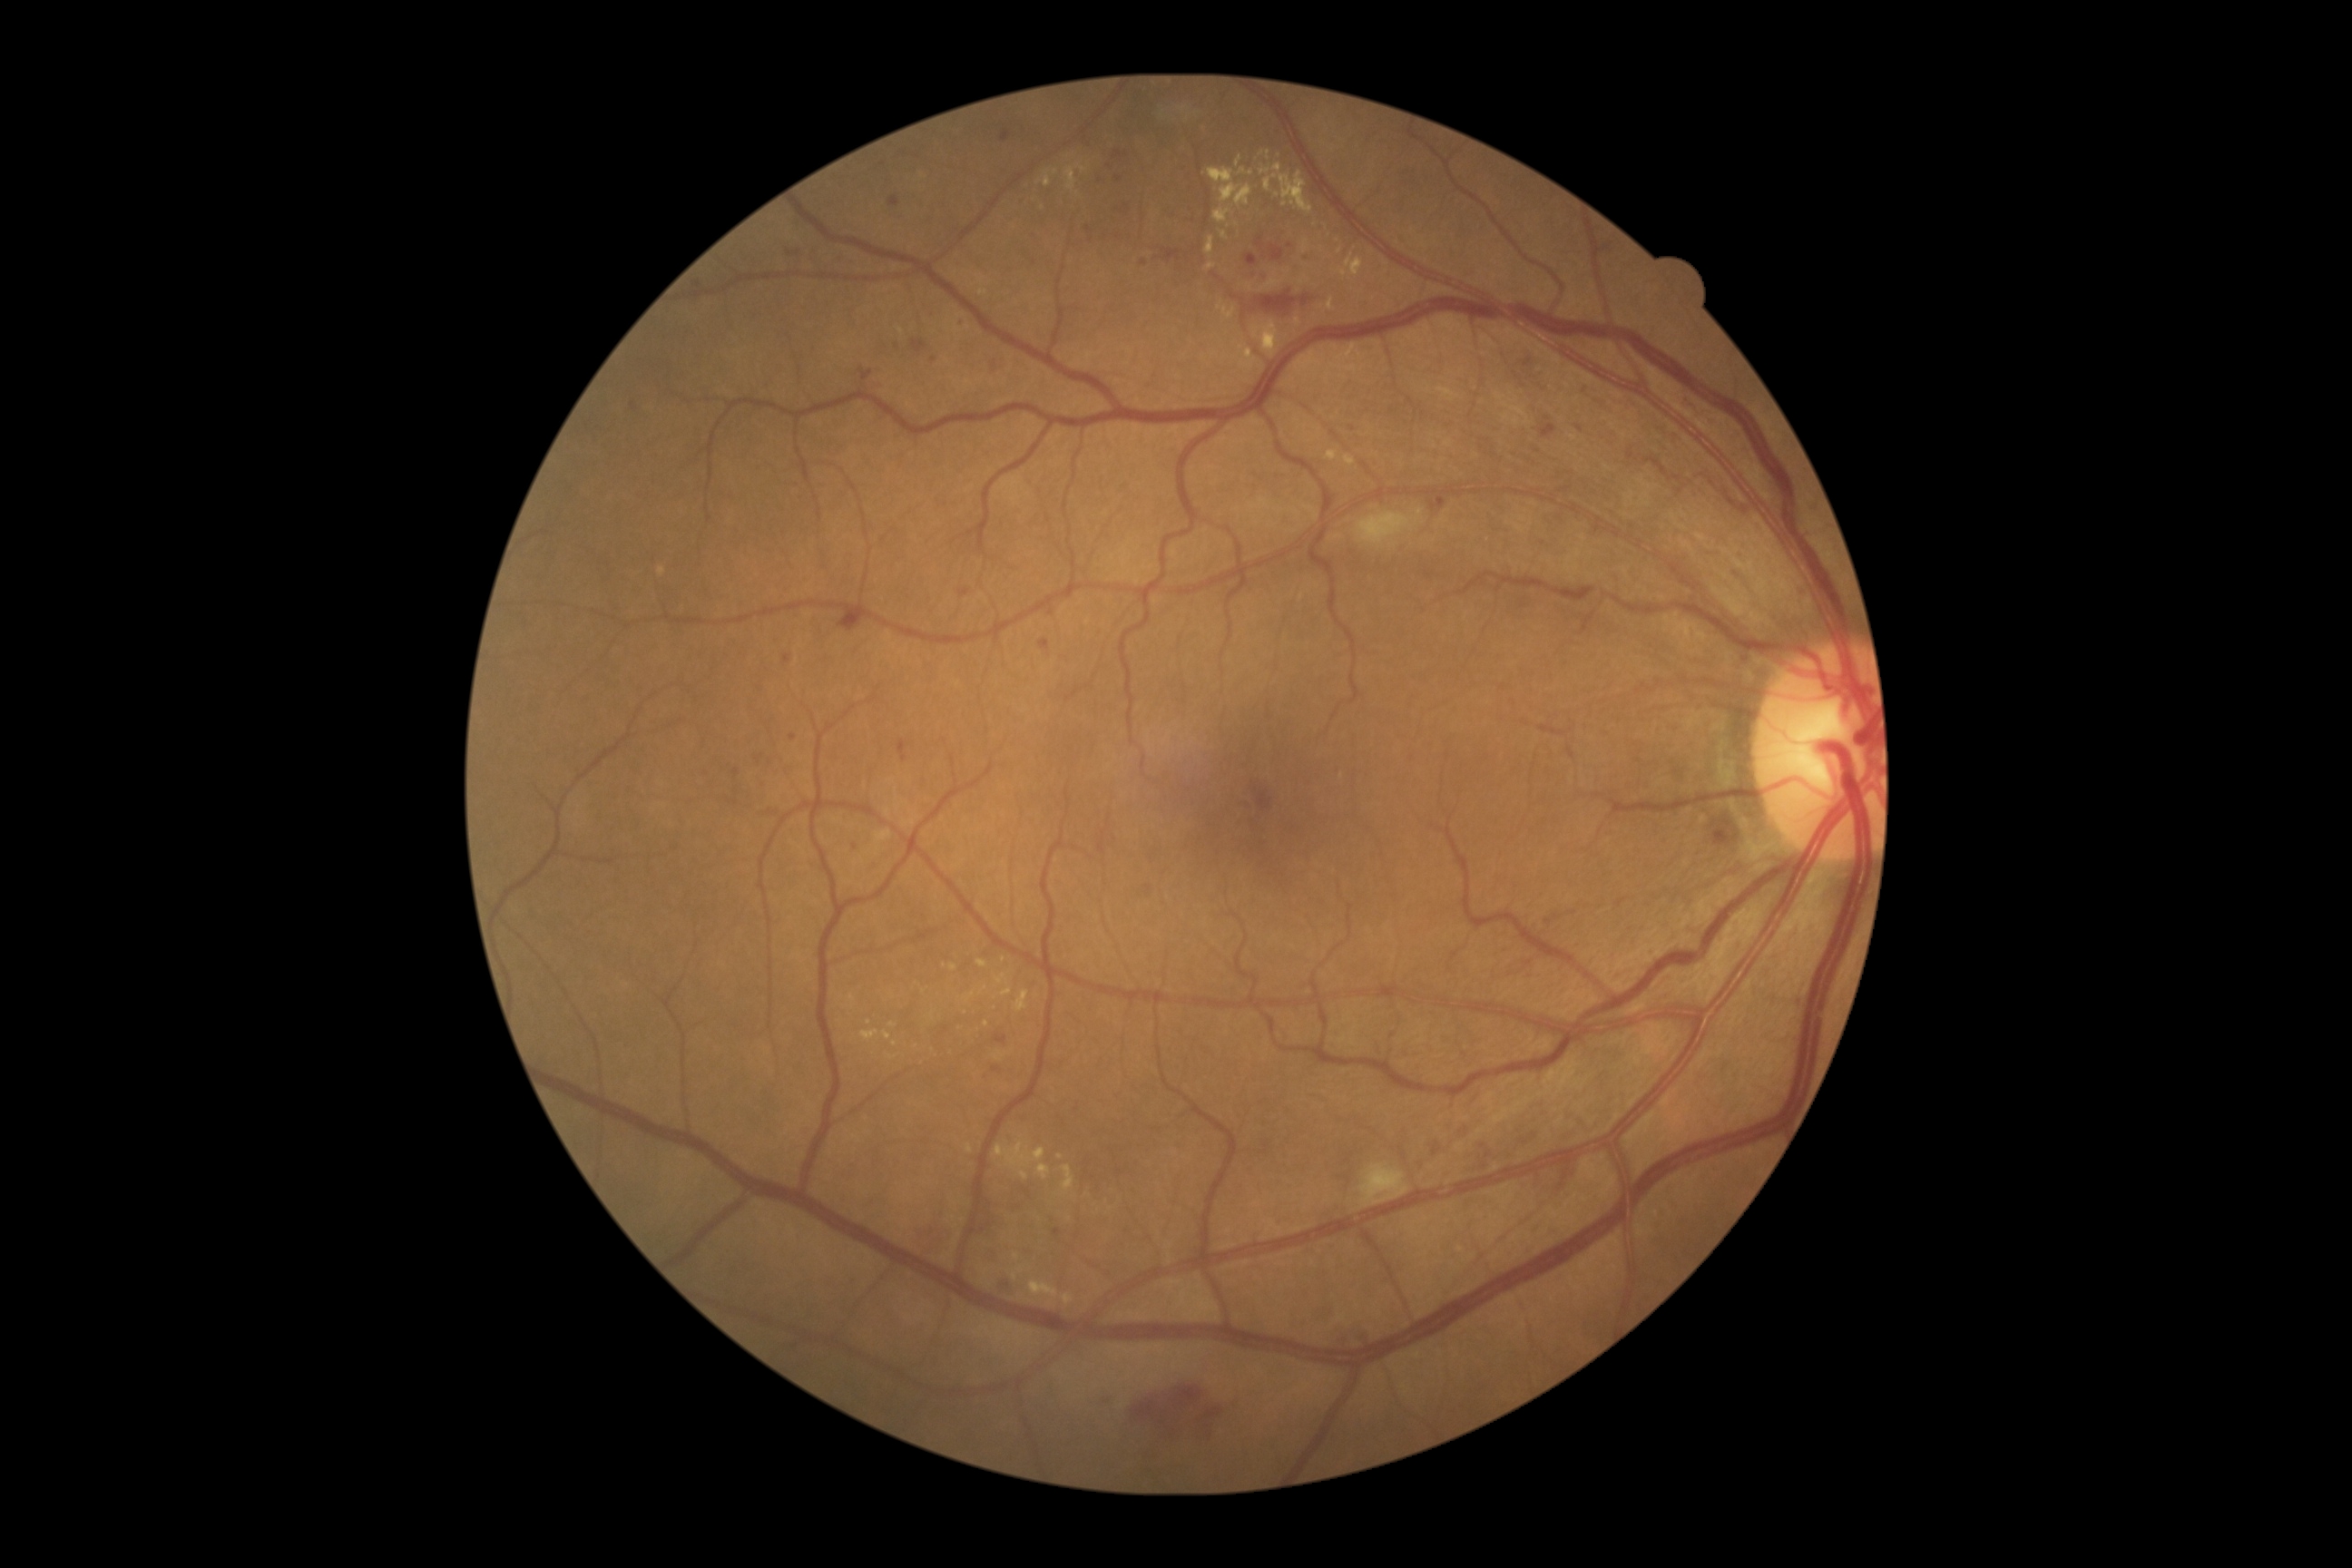 <lesions partial="true">
  <dr_grade>2</dr_grade>
  <se>Rect(1357, 509, 1422, 545) | Rect(1360, 1166, 1409, 1208)</se>
  <ma partial="true">Rect(1054, 1230, 1063, 1239) | Rect(859, 369, 874, 382) | Rect(912, 340, 928, 355) | Rect(1003, 130, 1012, 142) | Rect(1306, 248, 1311, 260) | Rect(1039, 640, 1050, 651) | Rect(790, 734, 798, 741) | Rect(888, 197, 899, 208)</ma>
  <ma_small_centers>point(1291, 246) | point(996, 1070) | point(1118, 155) | point(789, 254) | point(758, 761) | point(1118, 179)</ma_small_centers>
  <he>Rect(1115, 201, 1133, 217) | Rect(995, 1279, 1019, 1291) | Rect(838, 609, 865, 632) | Rect(1433, 498, 1446, 507) | Rect(990, 351, 1008, 377) | Rect(975, 1200, 999, 1235) | Rect(1302, 297, 1311, 306) | Rect(1084, 220, 1092, 240) | Rect(1716, 828, 1732, 843) | Rect(899, 741, 906, 763) | Rect(1524, 355, 1538, 373) | Rect(1133, 1386, 1230, 1446) | Rect(1257, 291, 1297, 313) | Rect(1133, 250, 1173, 266) | Rect(1540, 424, 1558, 438) | Rect(1253, 785, 1275, 812)</he>
  <ex partial="true">Rect(1030, 1280, 1059, 1298) | Rect(1235, 157, 1242, 168) | Rect(1264, 175, 1277, 191) | Rect(995, 975, 1008, 986) | Rect(1260, 152, 1271, 161) | Rect(1001, 988, 1014, 997) | Rect(1280, 172, 1313, 215) | Rect(1015, 992, 1030, 1012) | Rect(1220, 231, 1228, 240) | Rect(1063, 1166, 1075, 1191) | Rect(1326, 451, 1338, 462) | Rect(1021, 1171, 1030, 1181) | Rect(1057, 1153, 1063, 1161) | Rect(888, 1023, 897, 1028) | Rect(1253, 322, 1279, 357)</ex>
  <ex_small_centers>point(1324, 144) | point(987, 1025) | point(1079, 195) | point(944, 966)</ex_small_centers>
</lesions>